DR severity per modified Davis staging: 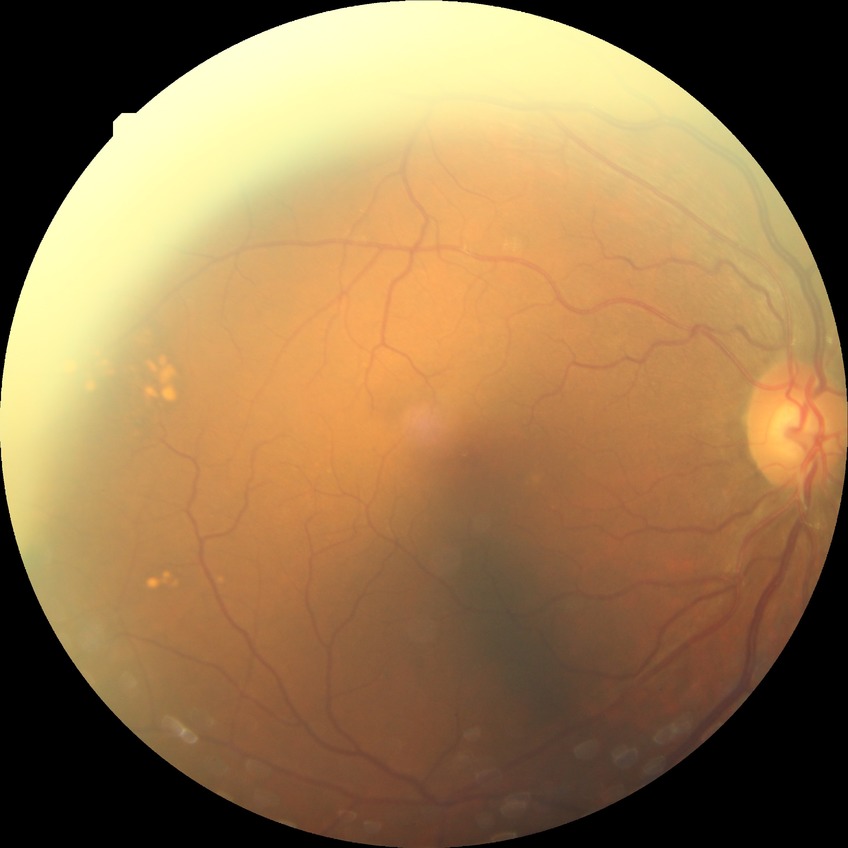

Annotations:
• diabetic retinopathy (DR) — NDR (no diabetic retinopathy)